CFP.
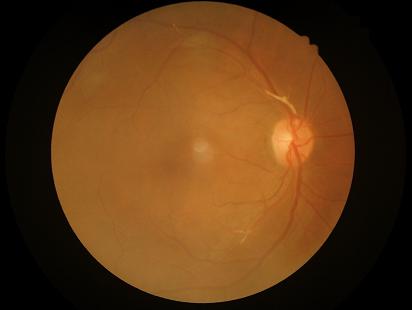
Out of focus; structures are indistinct. Adequate contrast for distinguishing structures. Overall quality is good and the image is gradable. No over- or under-exposure.